1240 x 1240 pixels. Acquired on the Phoenix ICON. Wide-field contact fundus photograph of an infant:
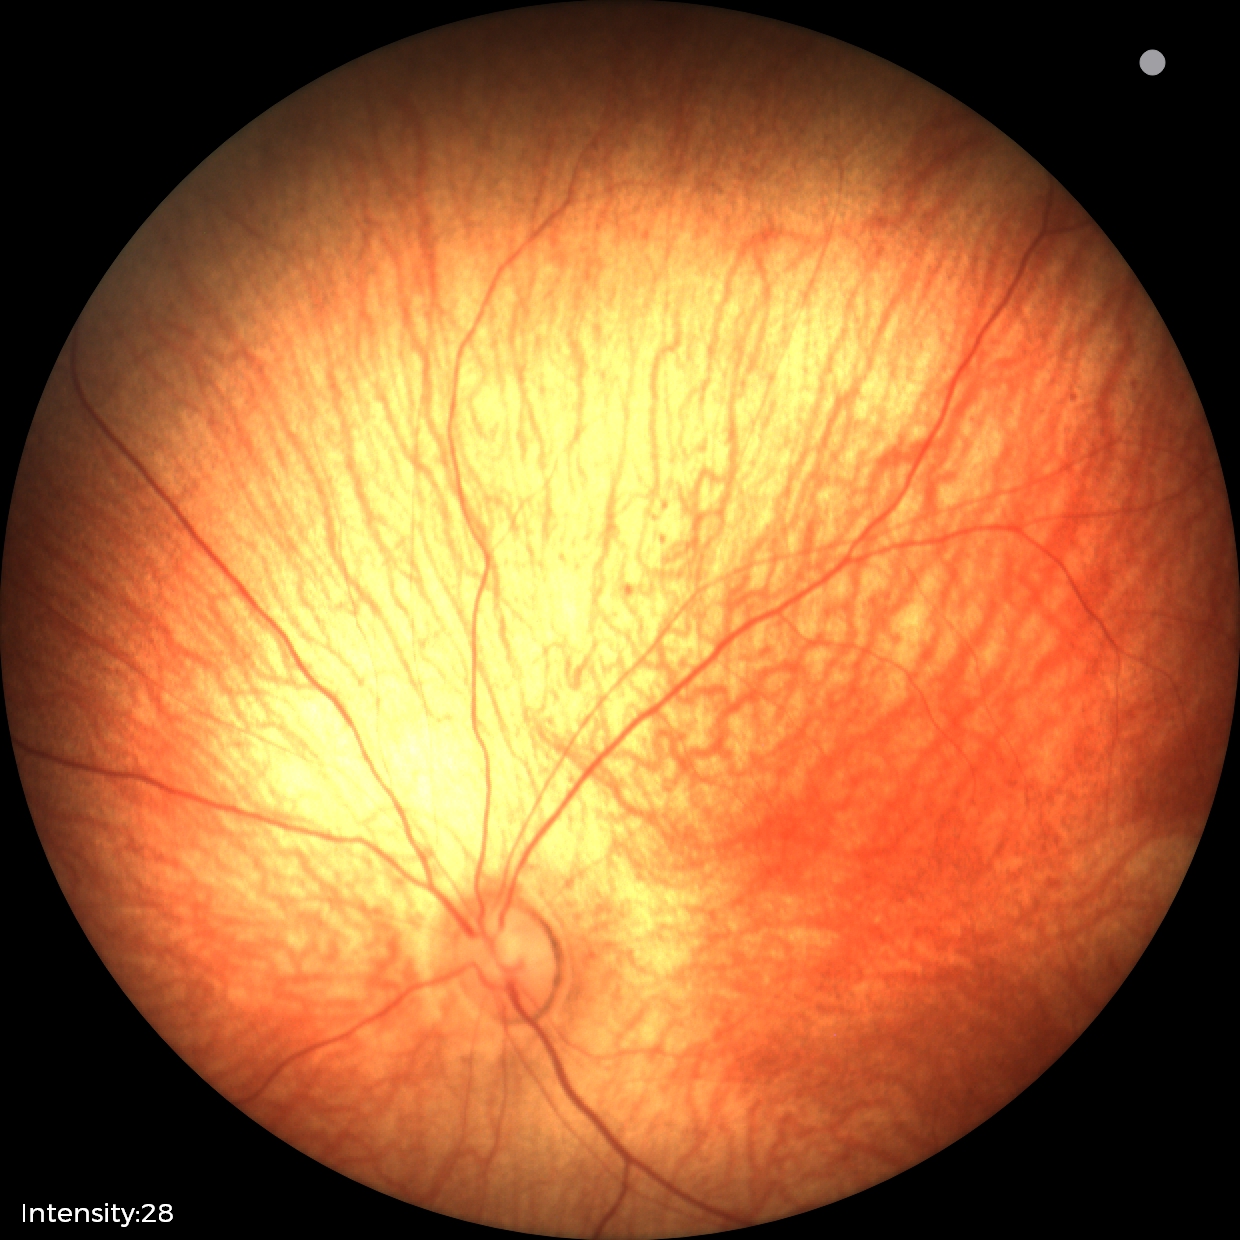
Screening examination diagnosed as physiological.